45° field of view. CFP. 2212 by 1659 pixels: 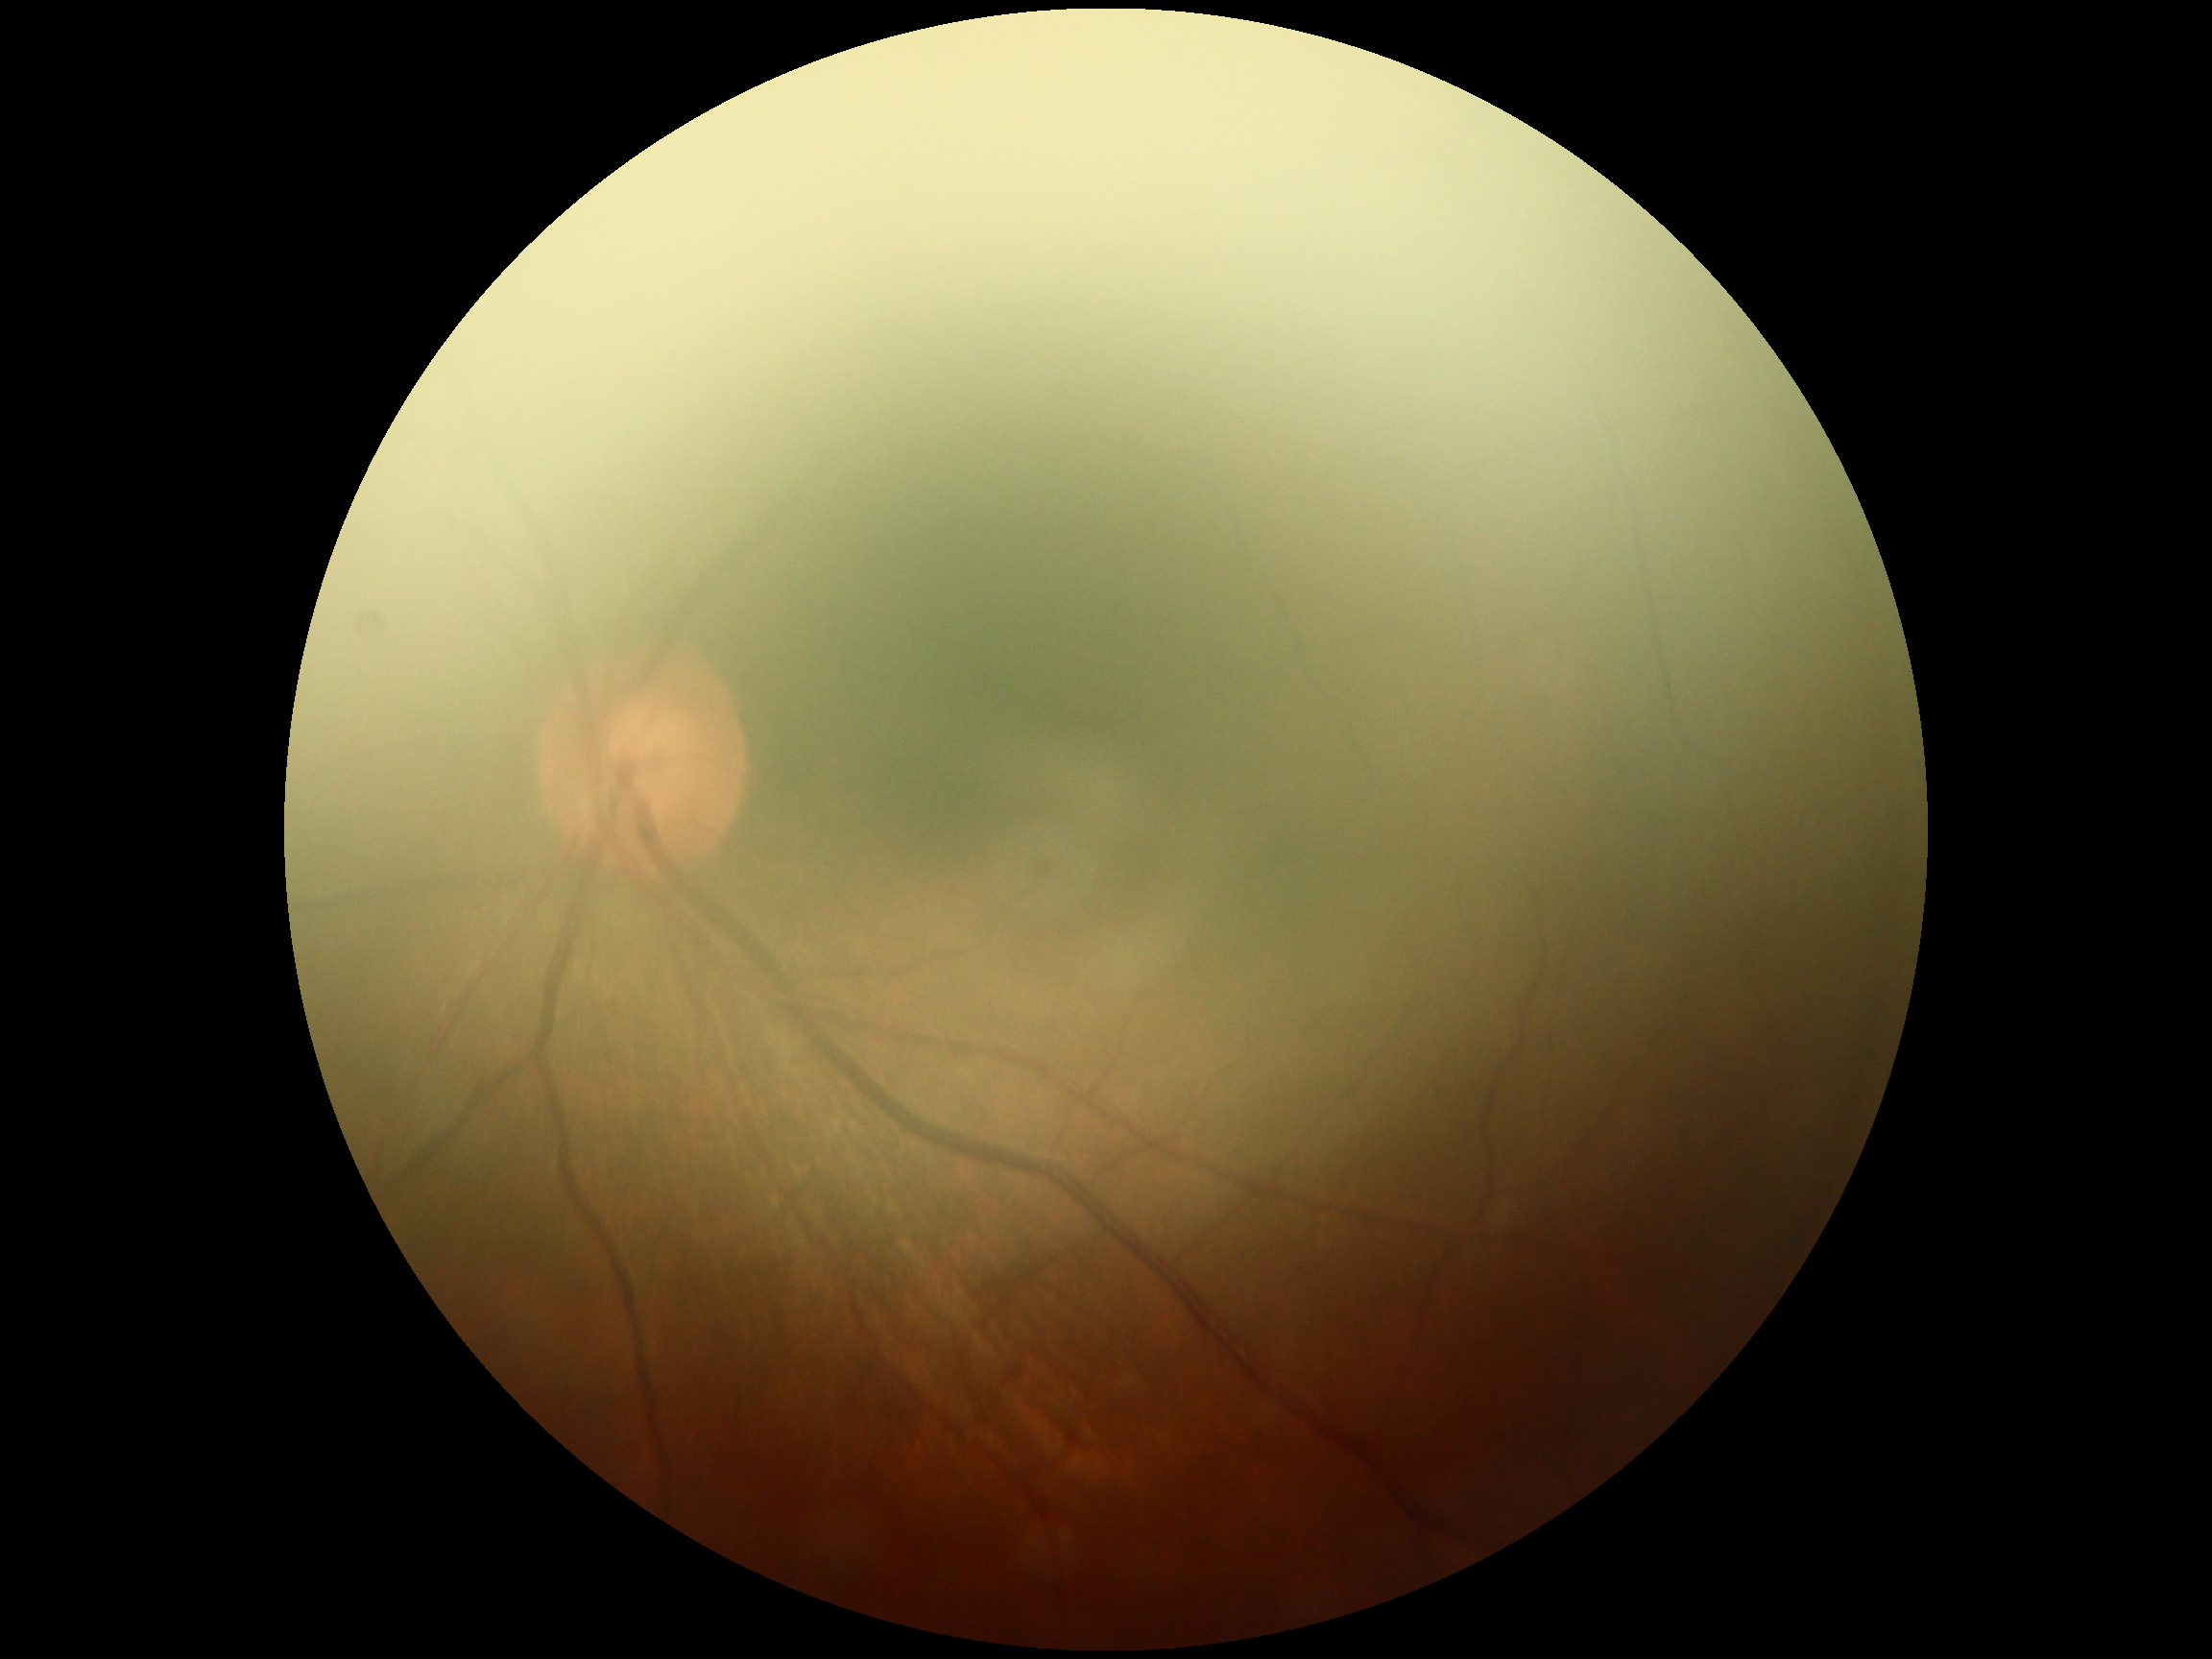 DR stage = ungradable